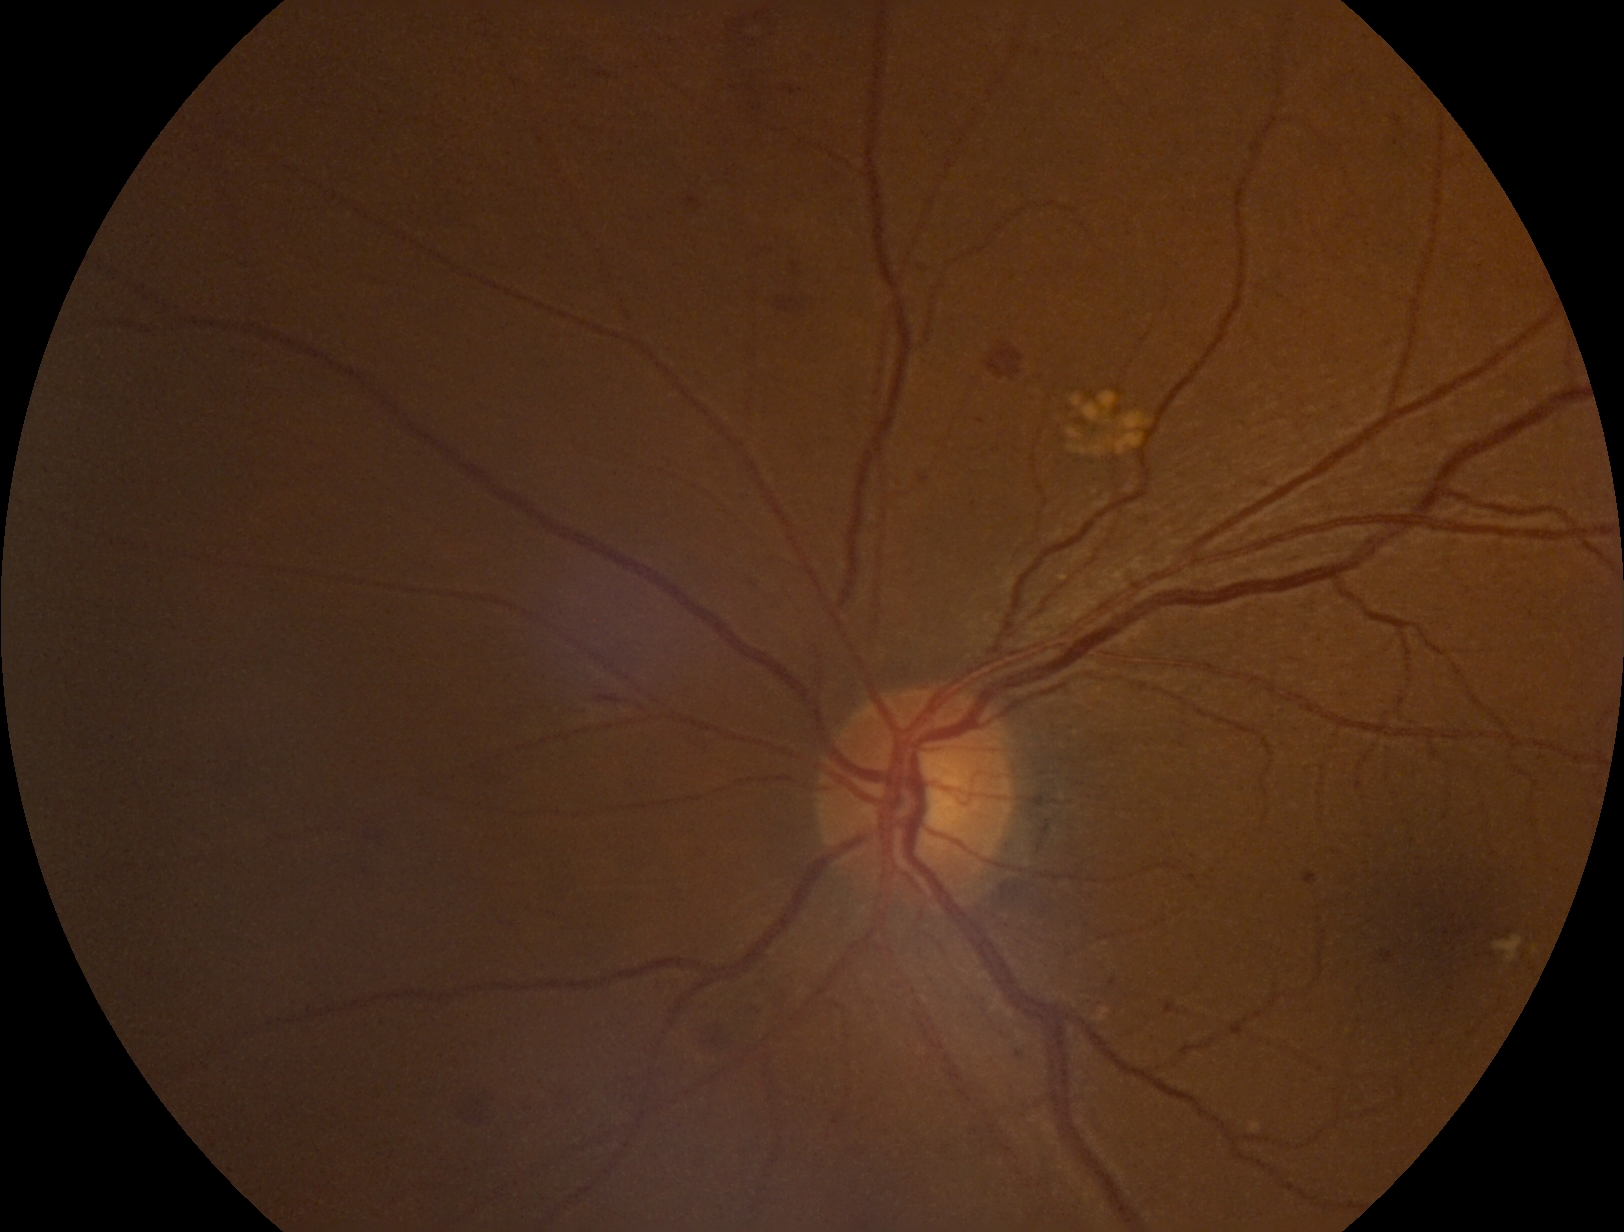 DR severity: grade 2 (moderate NPDR)